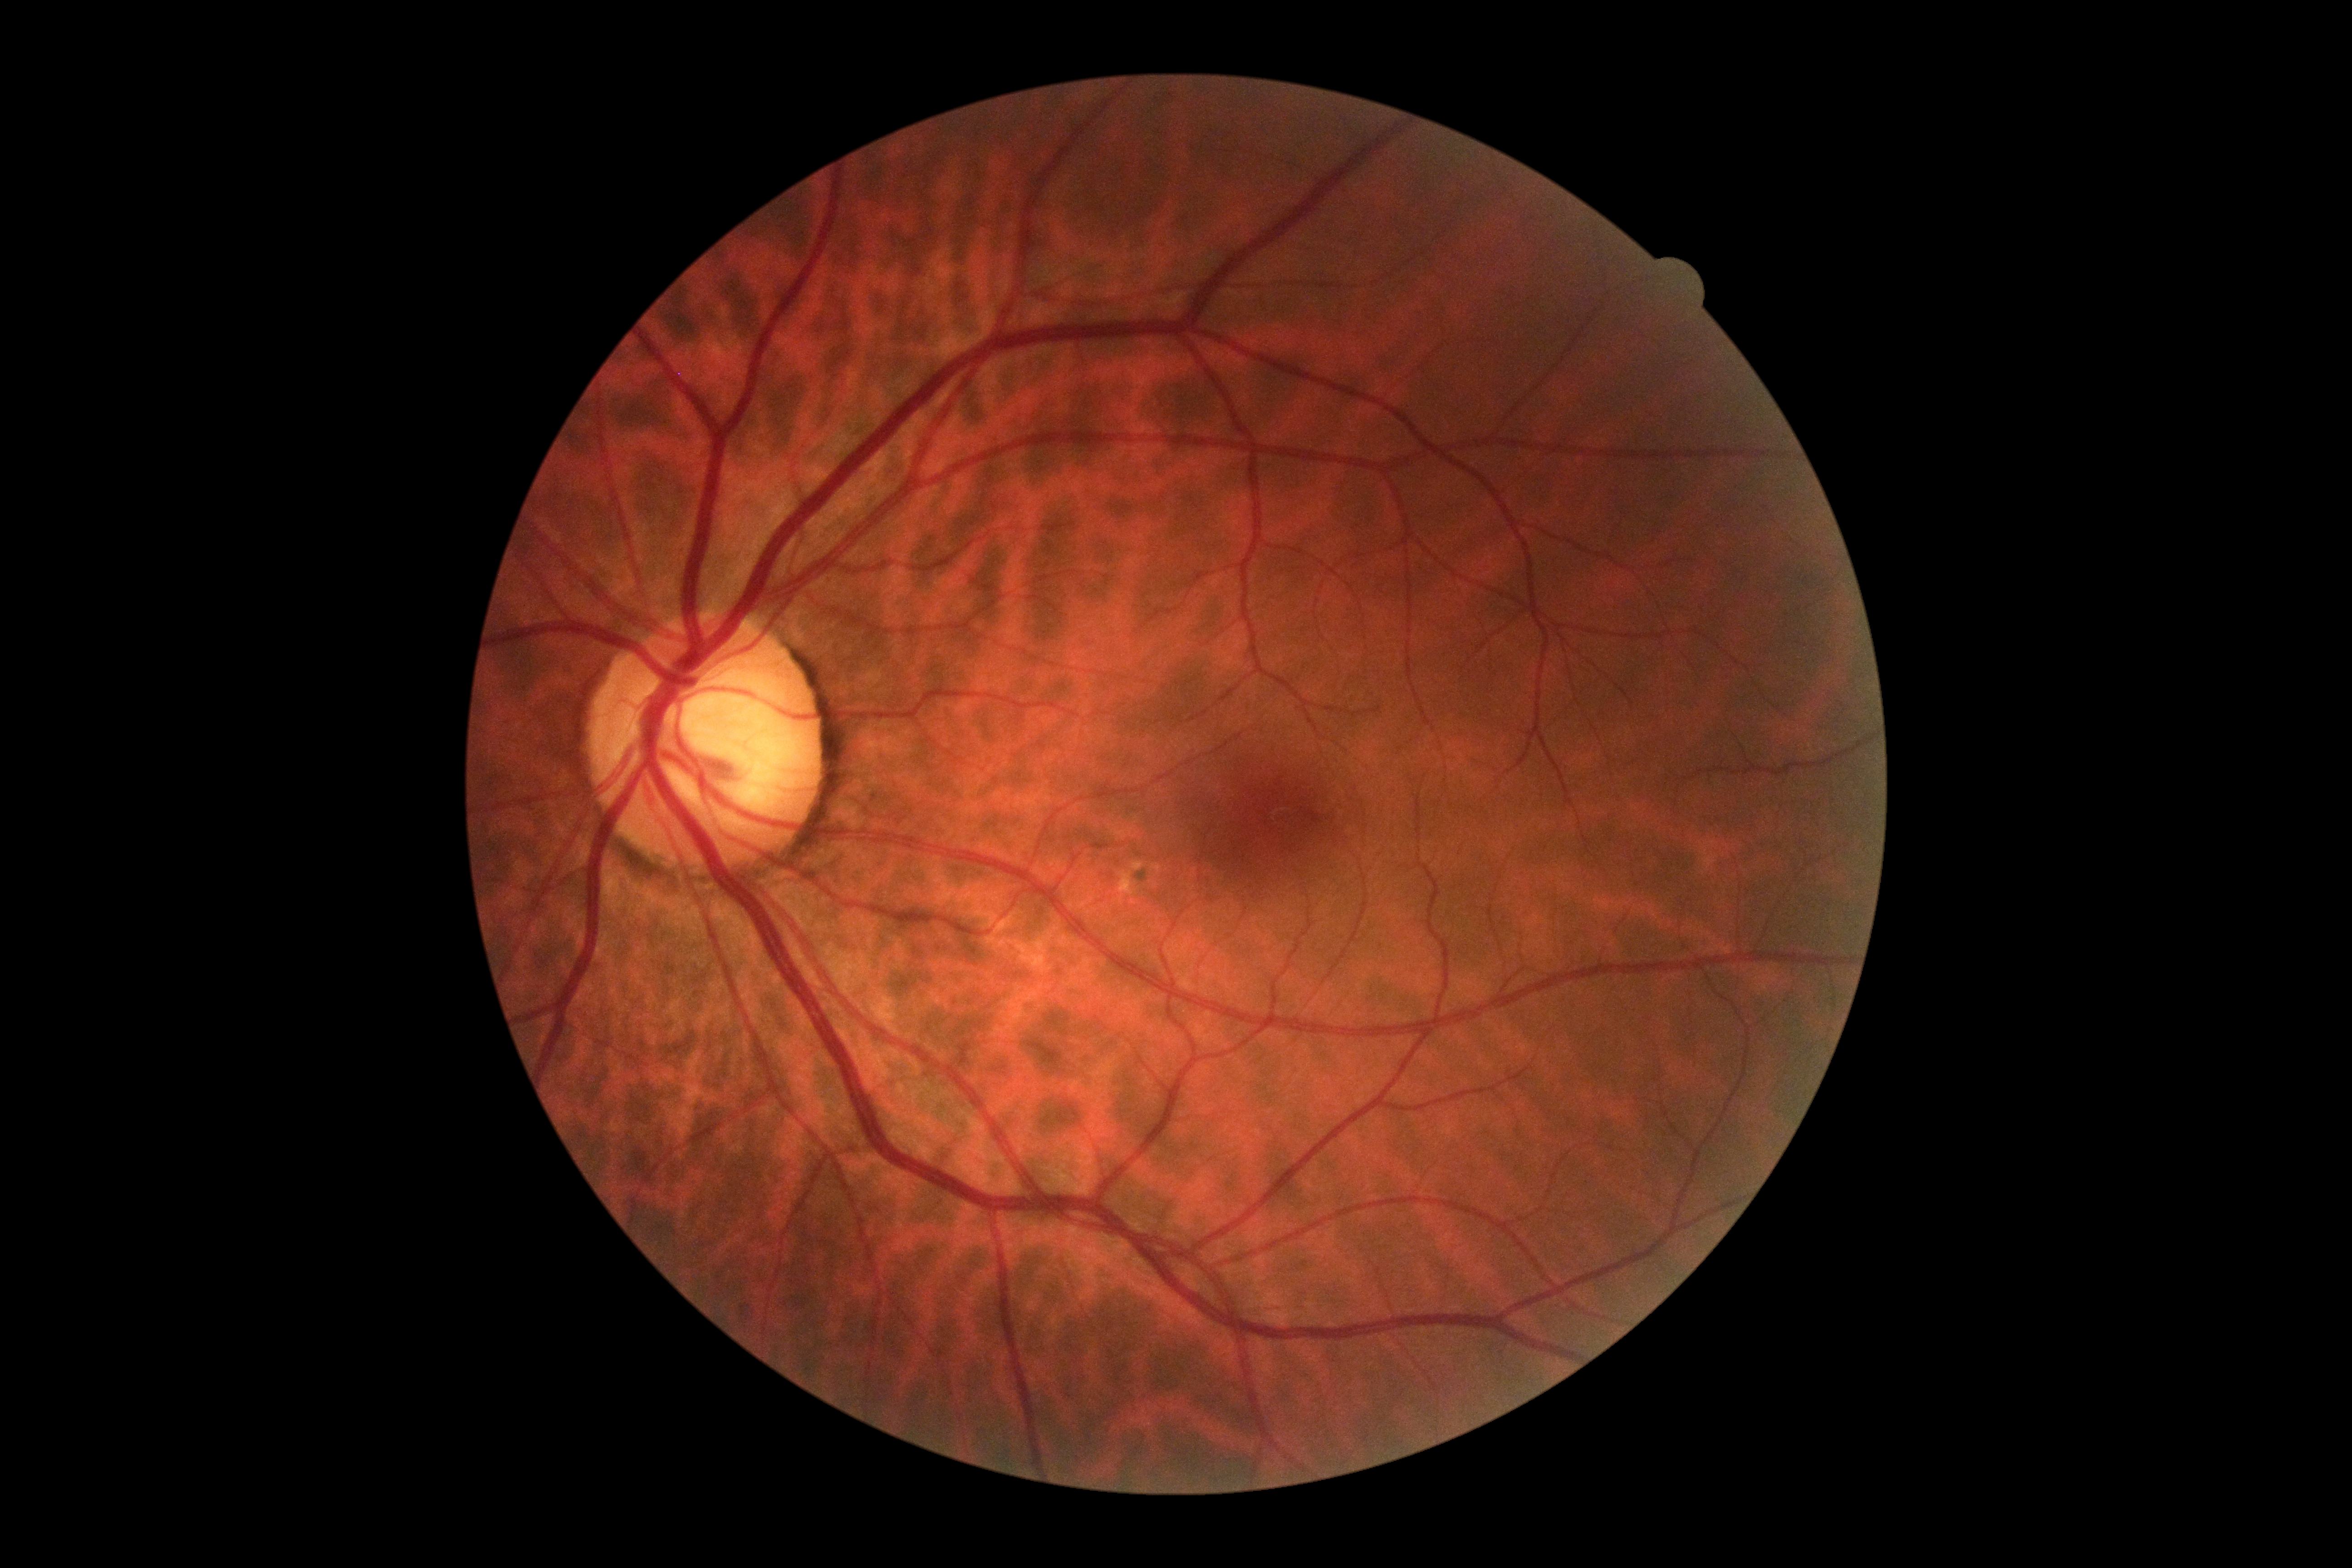 - DR severity — grade 0